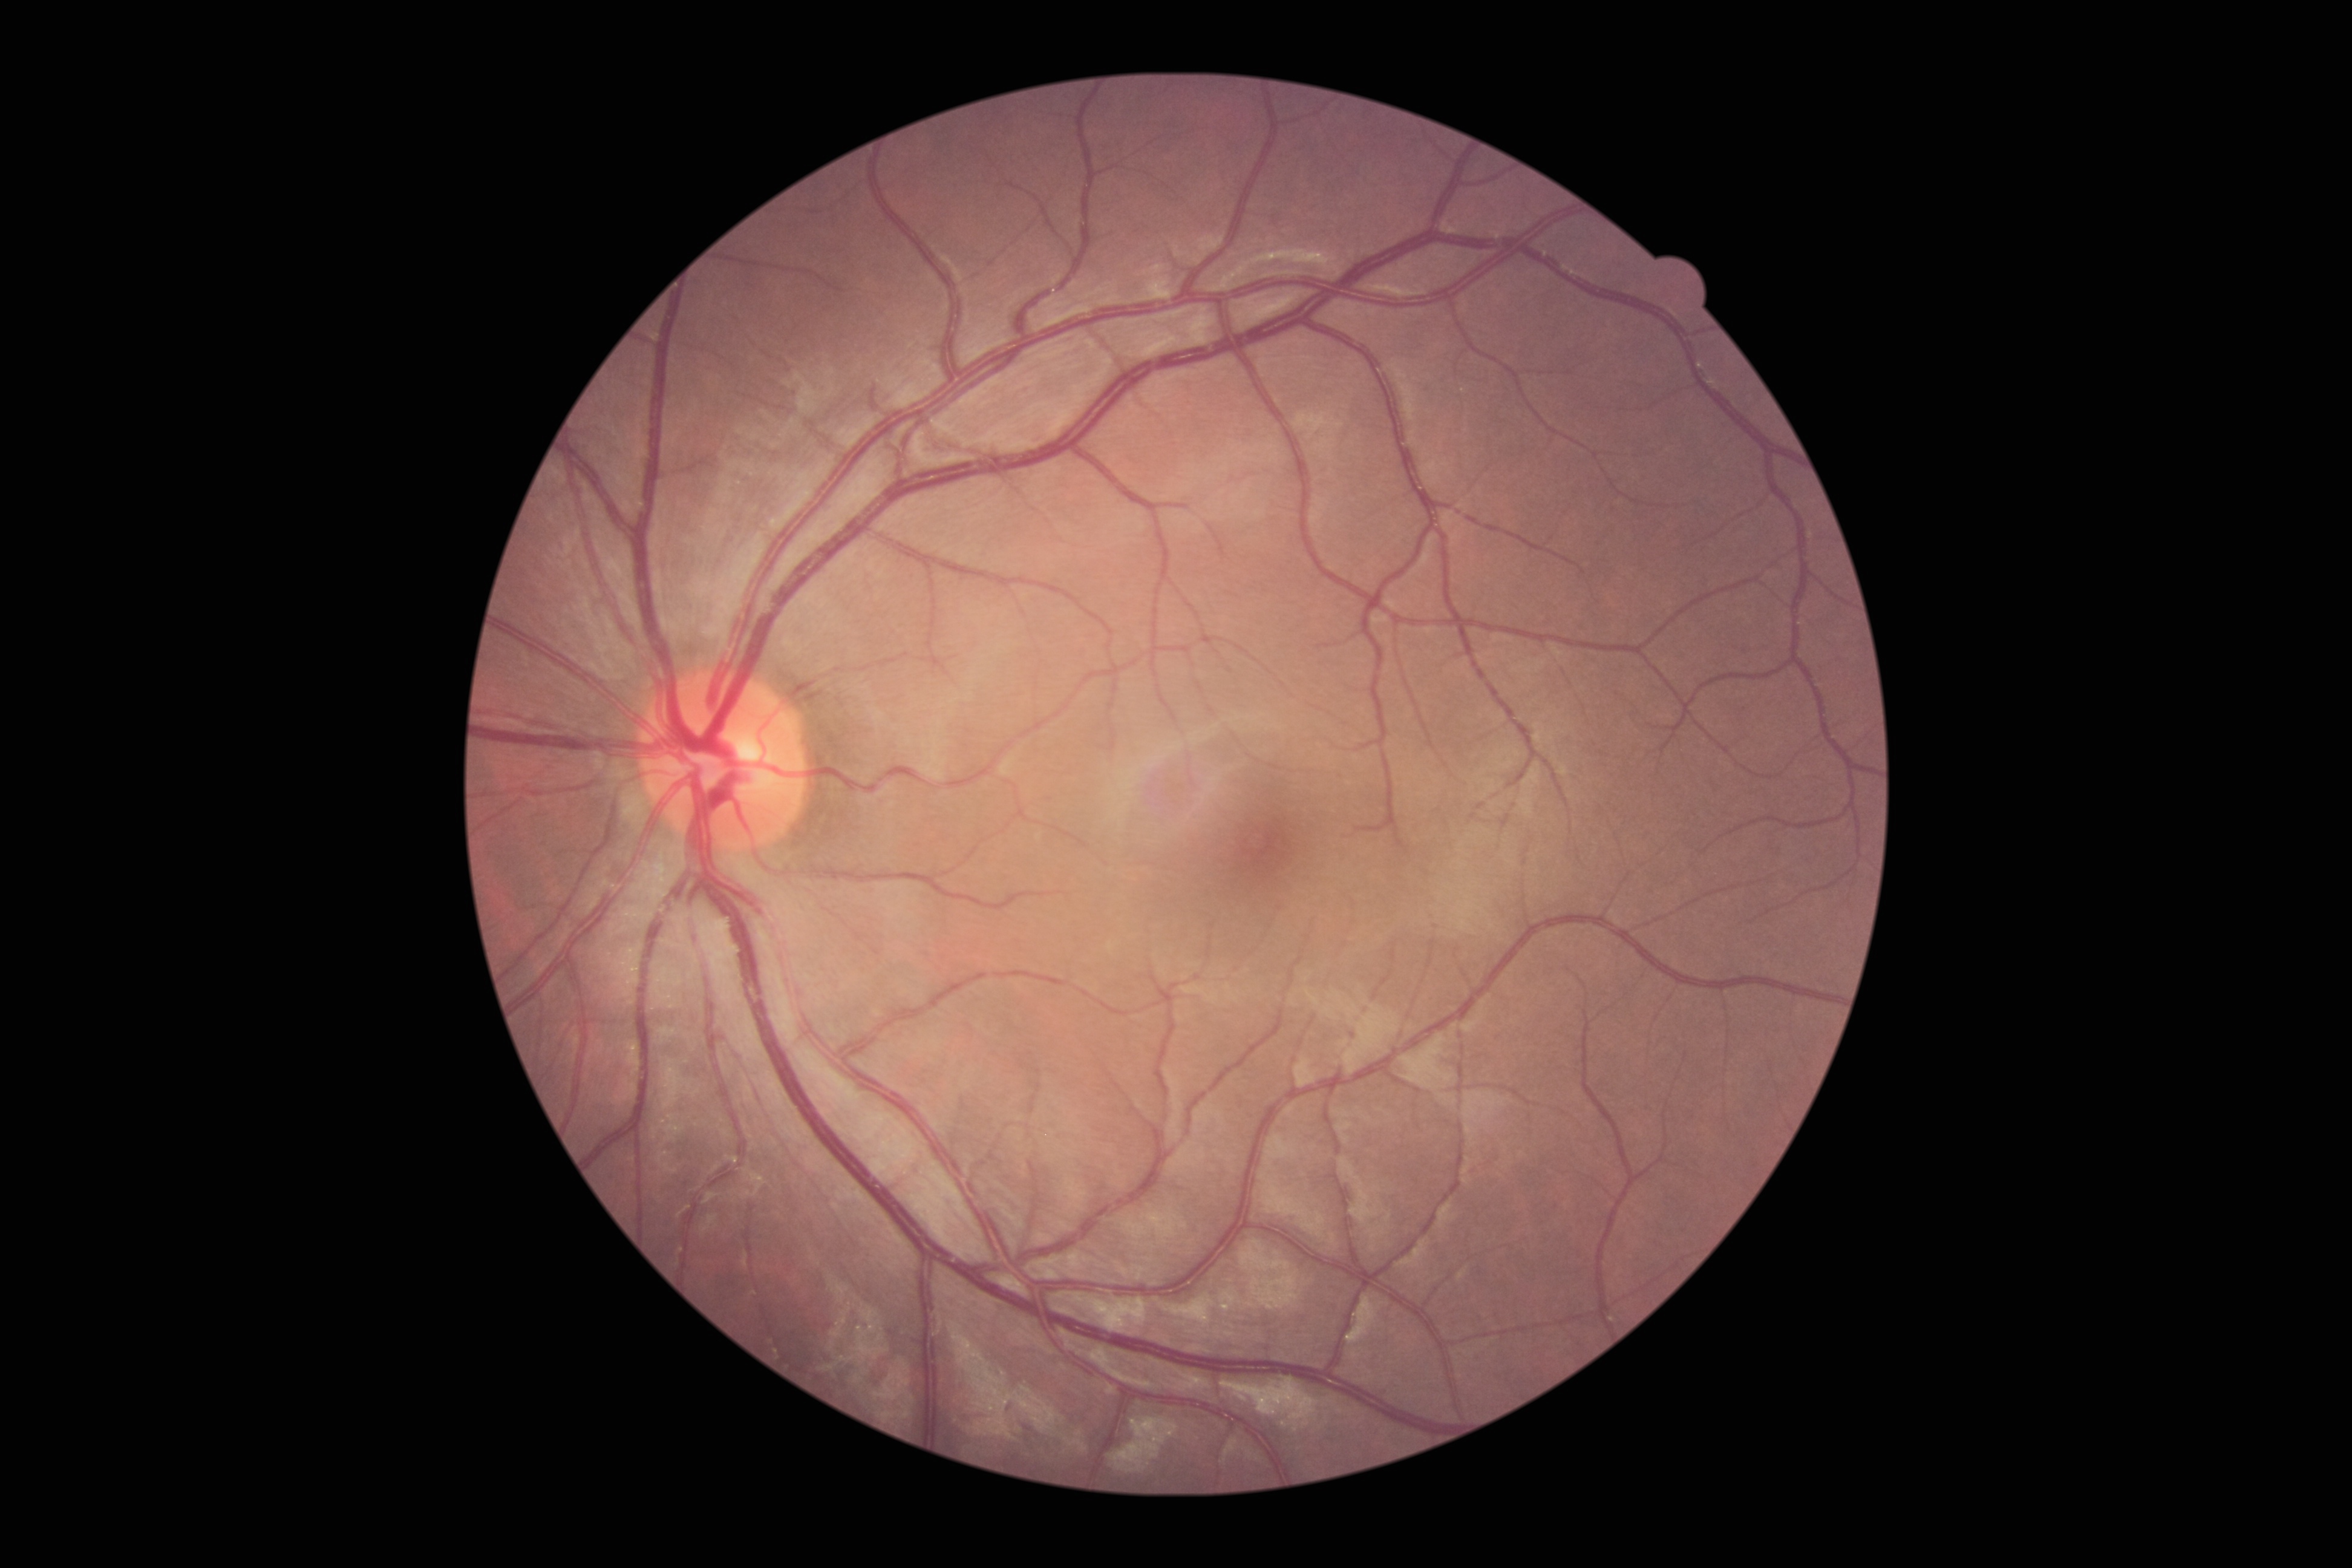
• DR severity — no apparent diabetic retinopathy (grade 0)